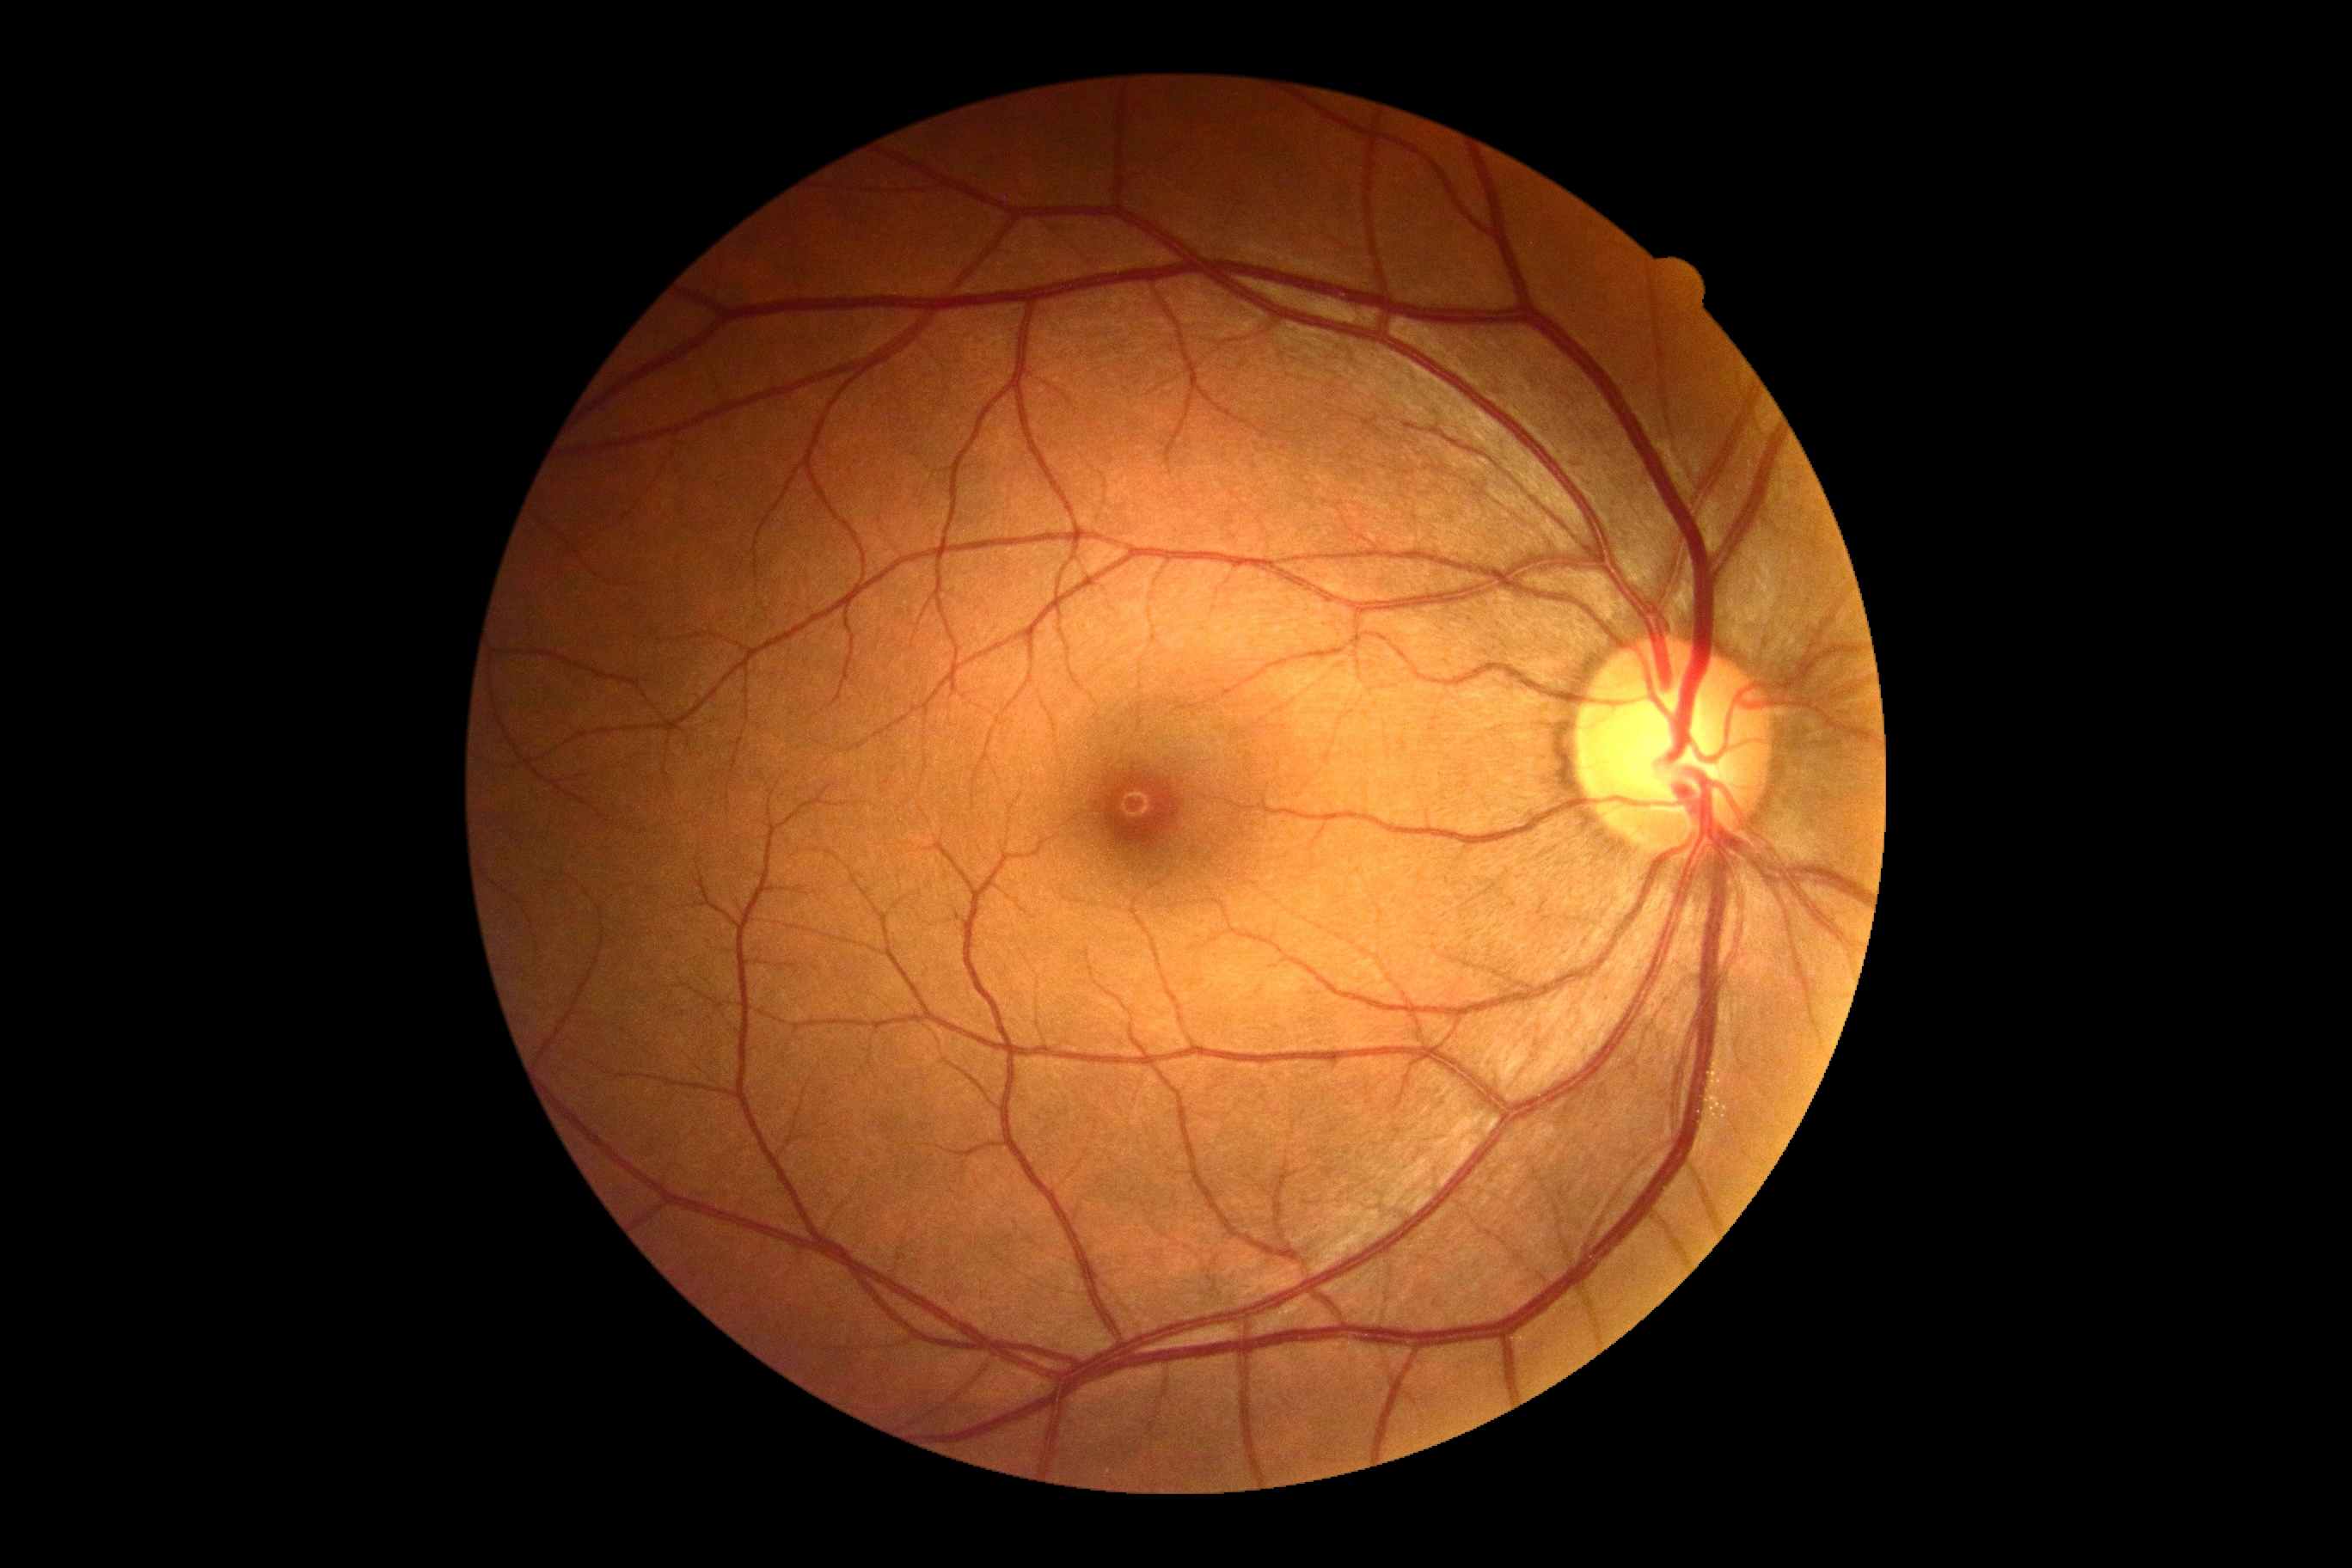

DR impression = no apparent DR
DR stage = 0 — no visible signs of diabetic retinopathy